130° field of view (Clarity RetCam 3). Infant wide-field retinal image: 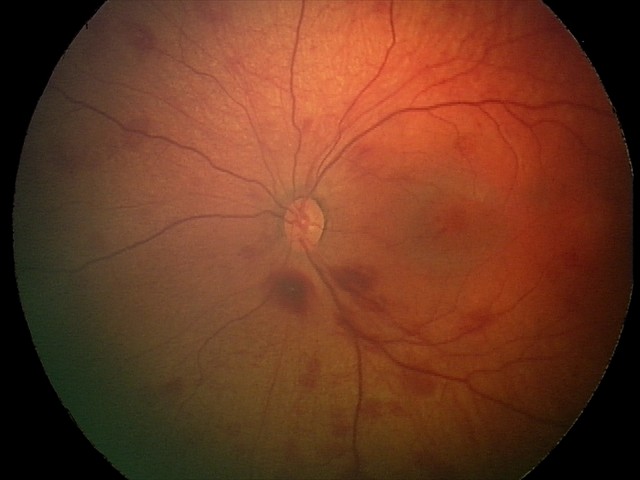 Screening diagnosis = retinal hemorrhages.